2352 by 1568 pixels. Color fundus image.
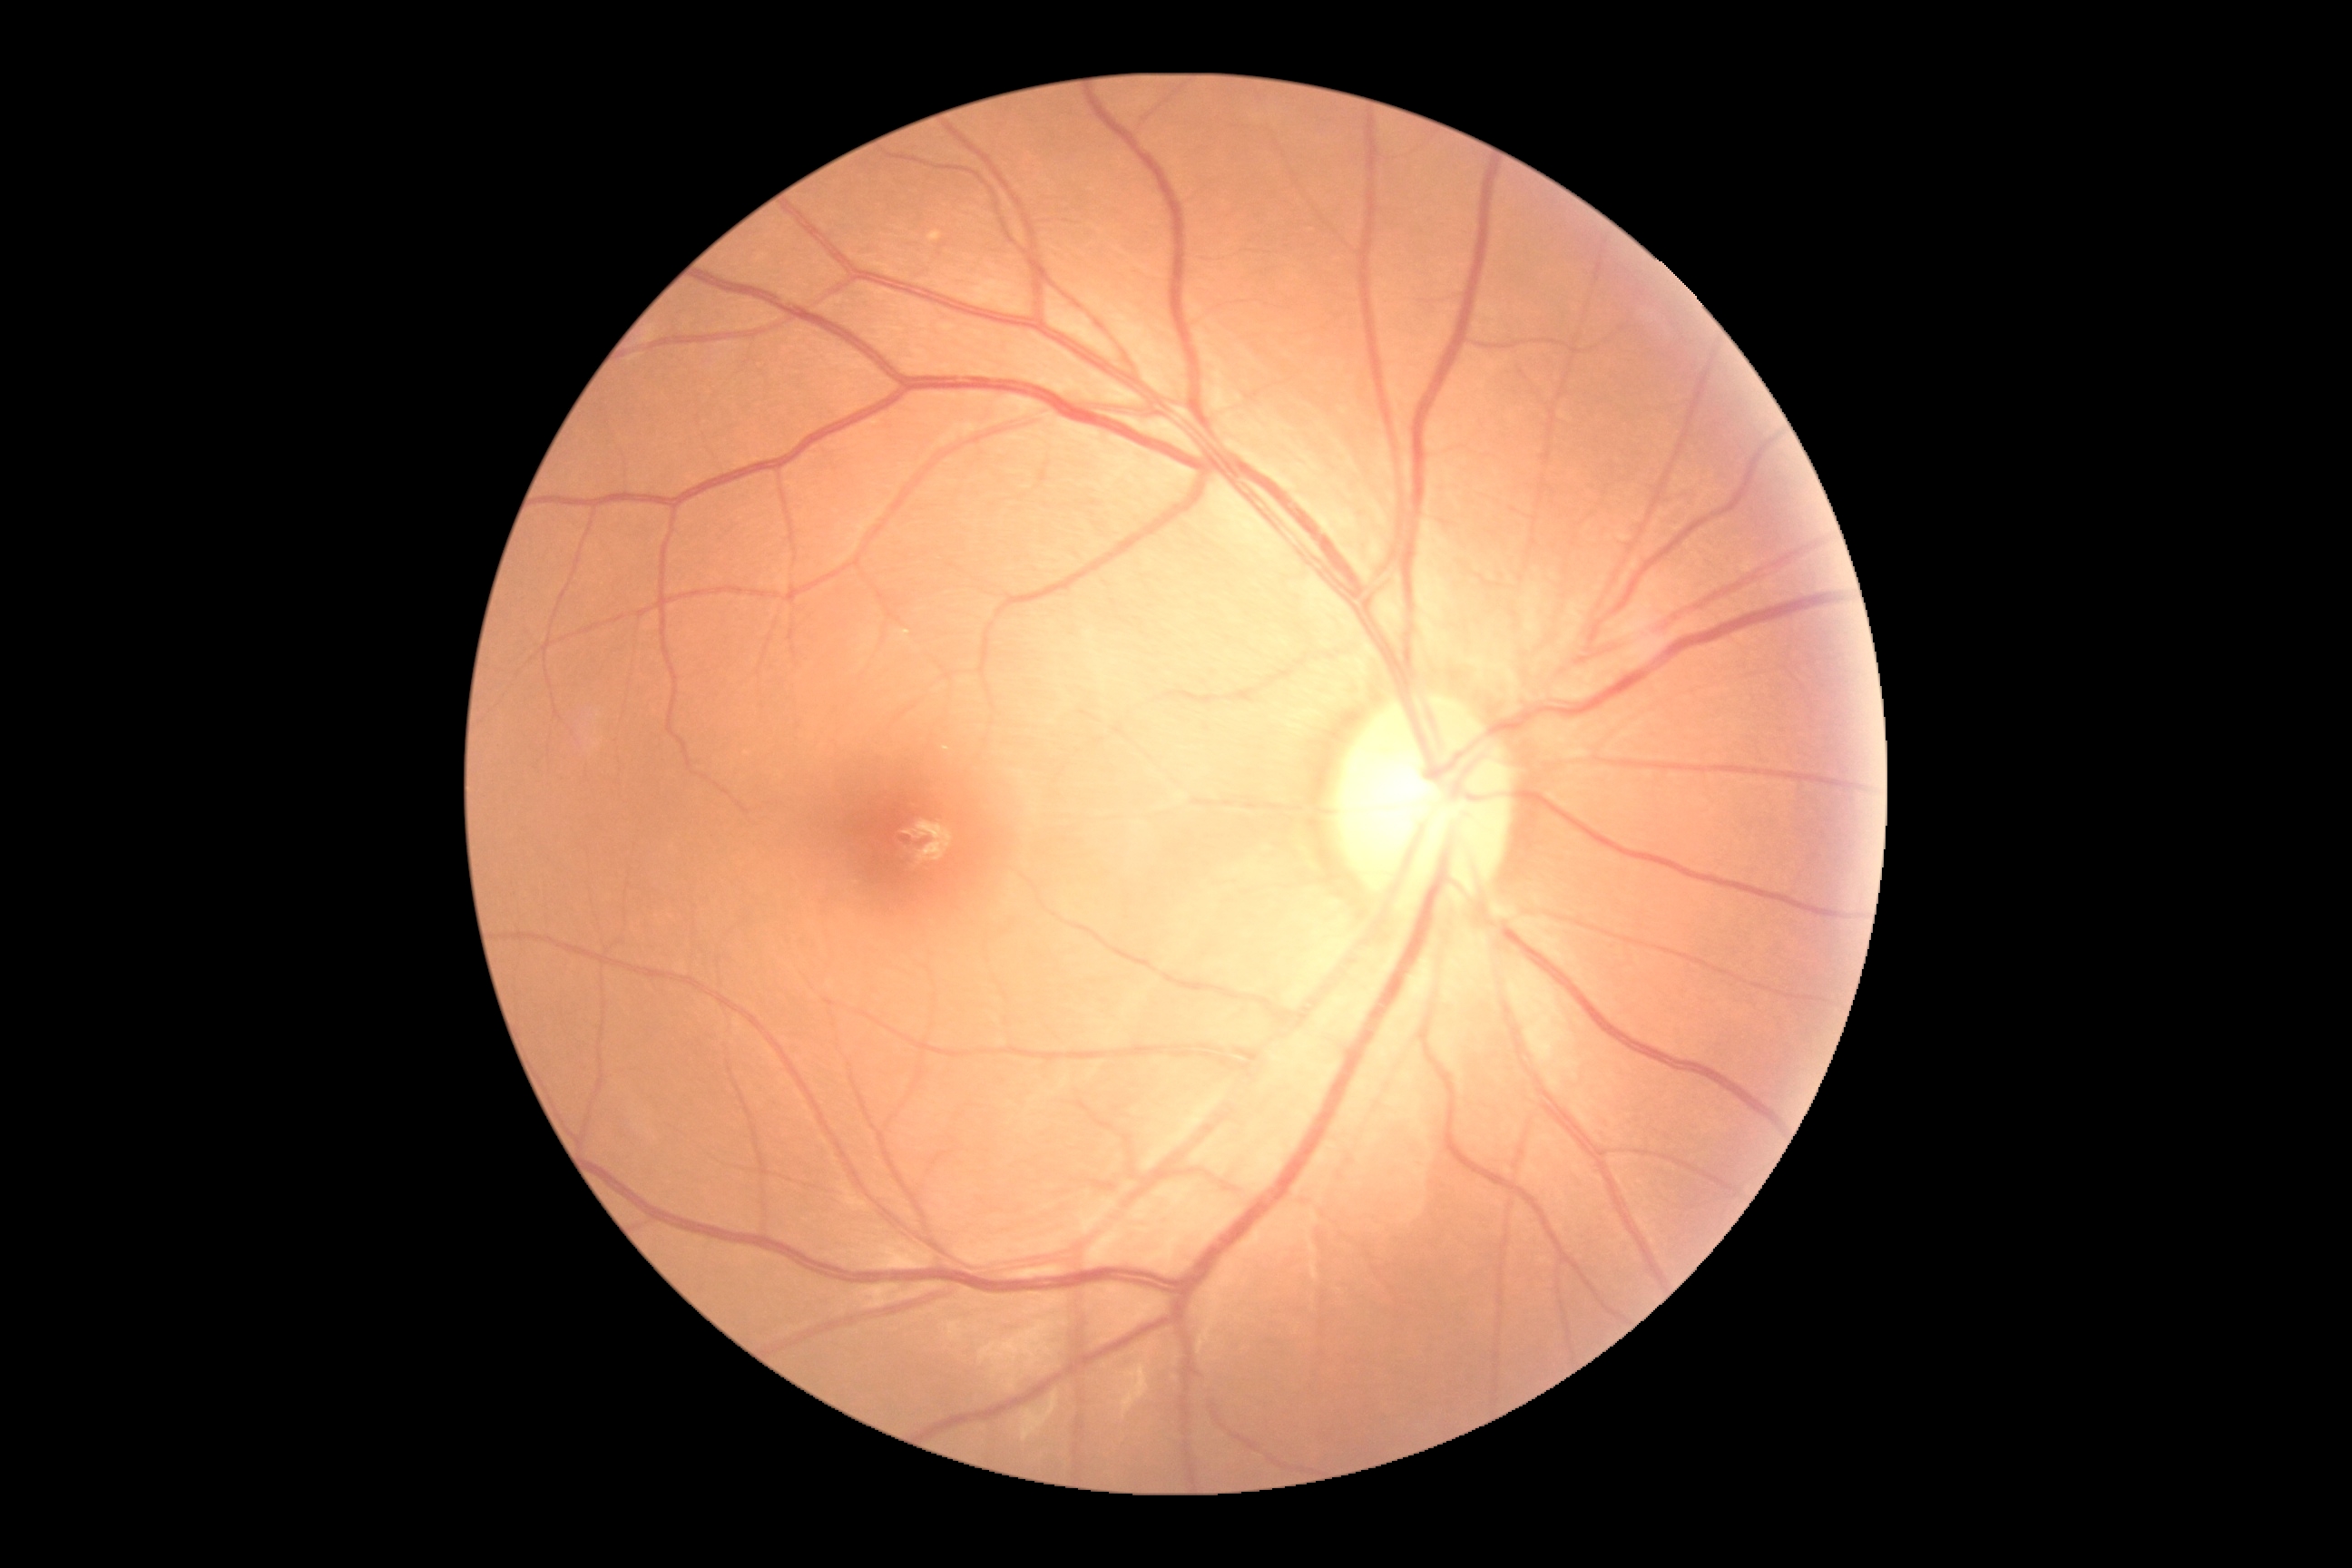

Diabetic retinopathy (DR) is grade 0.